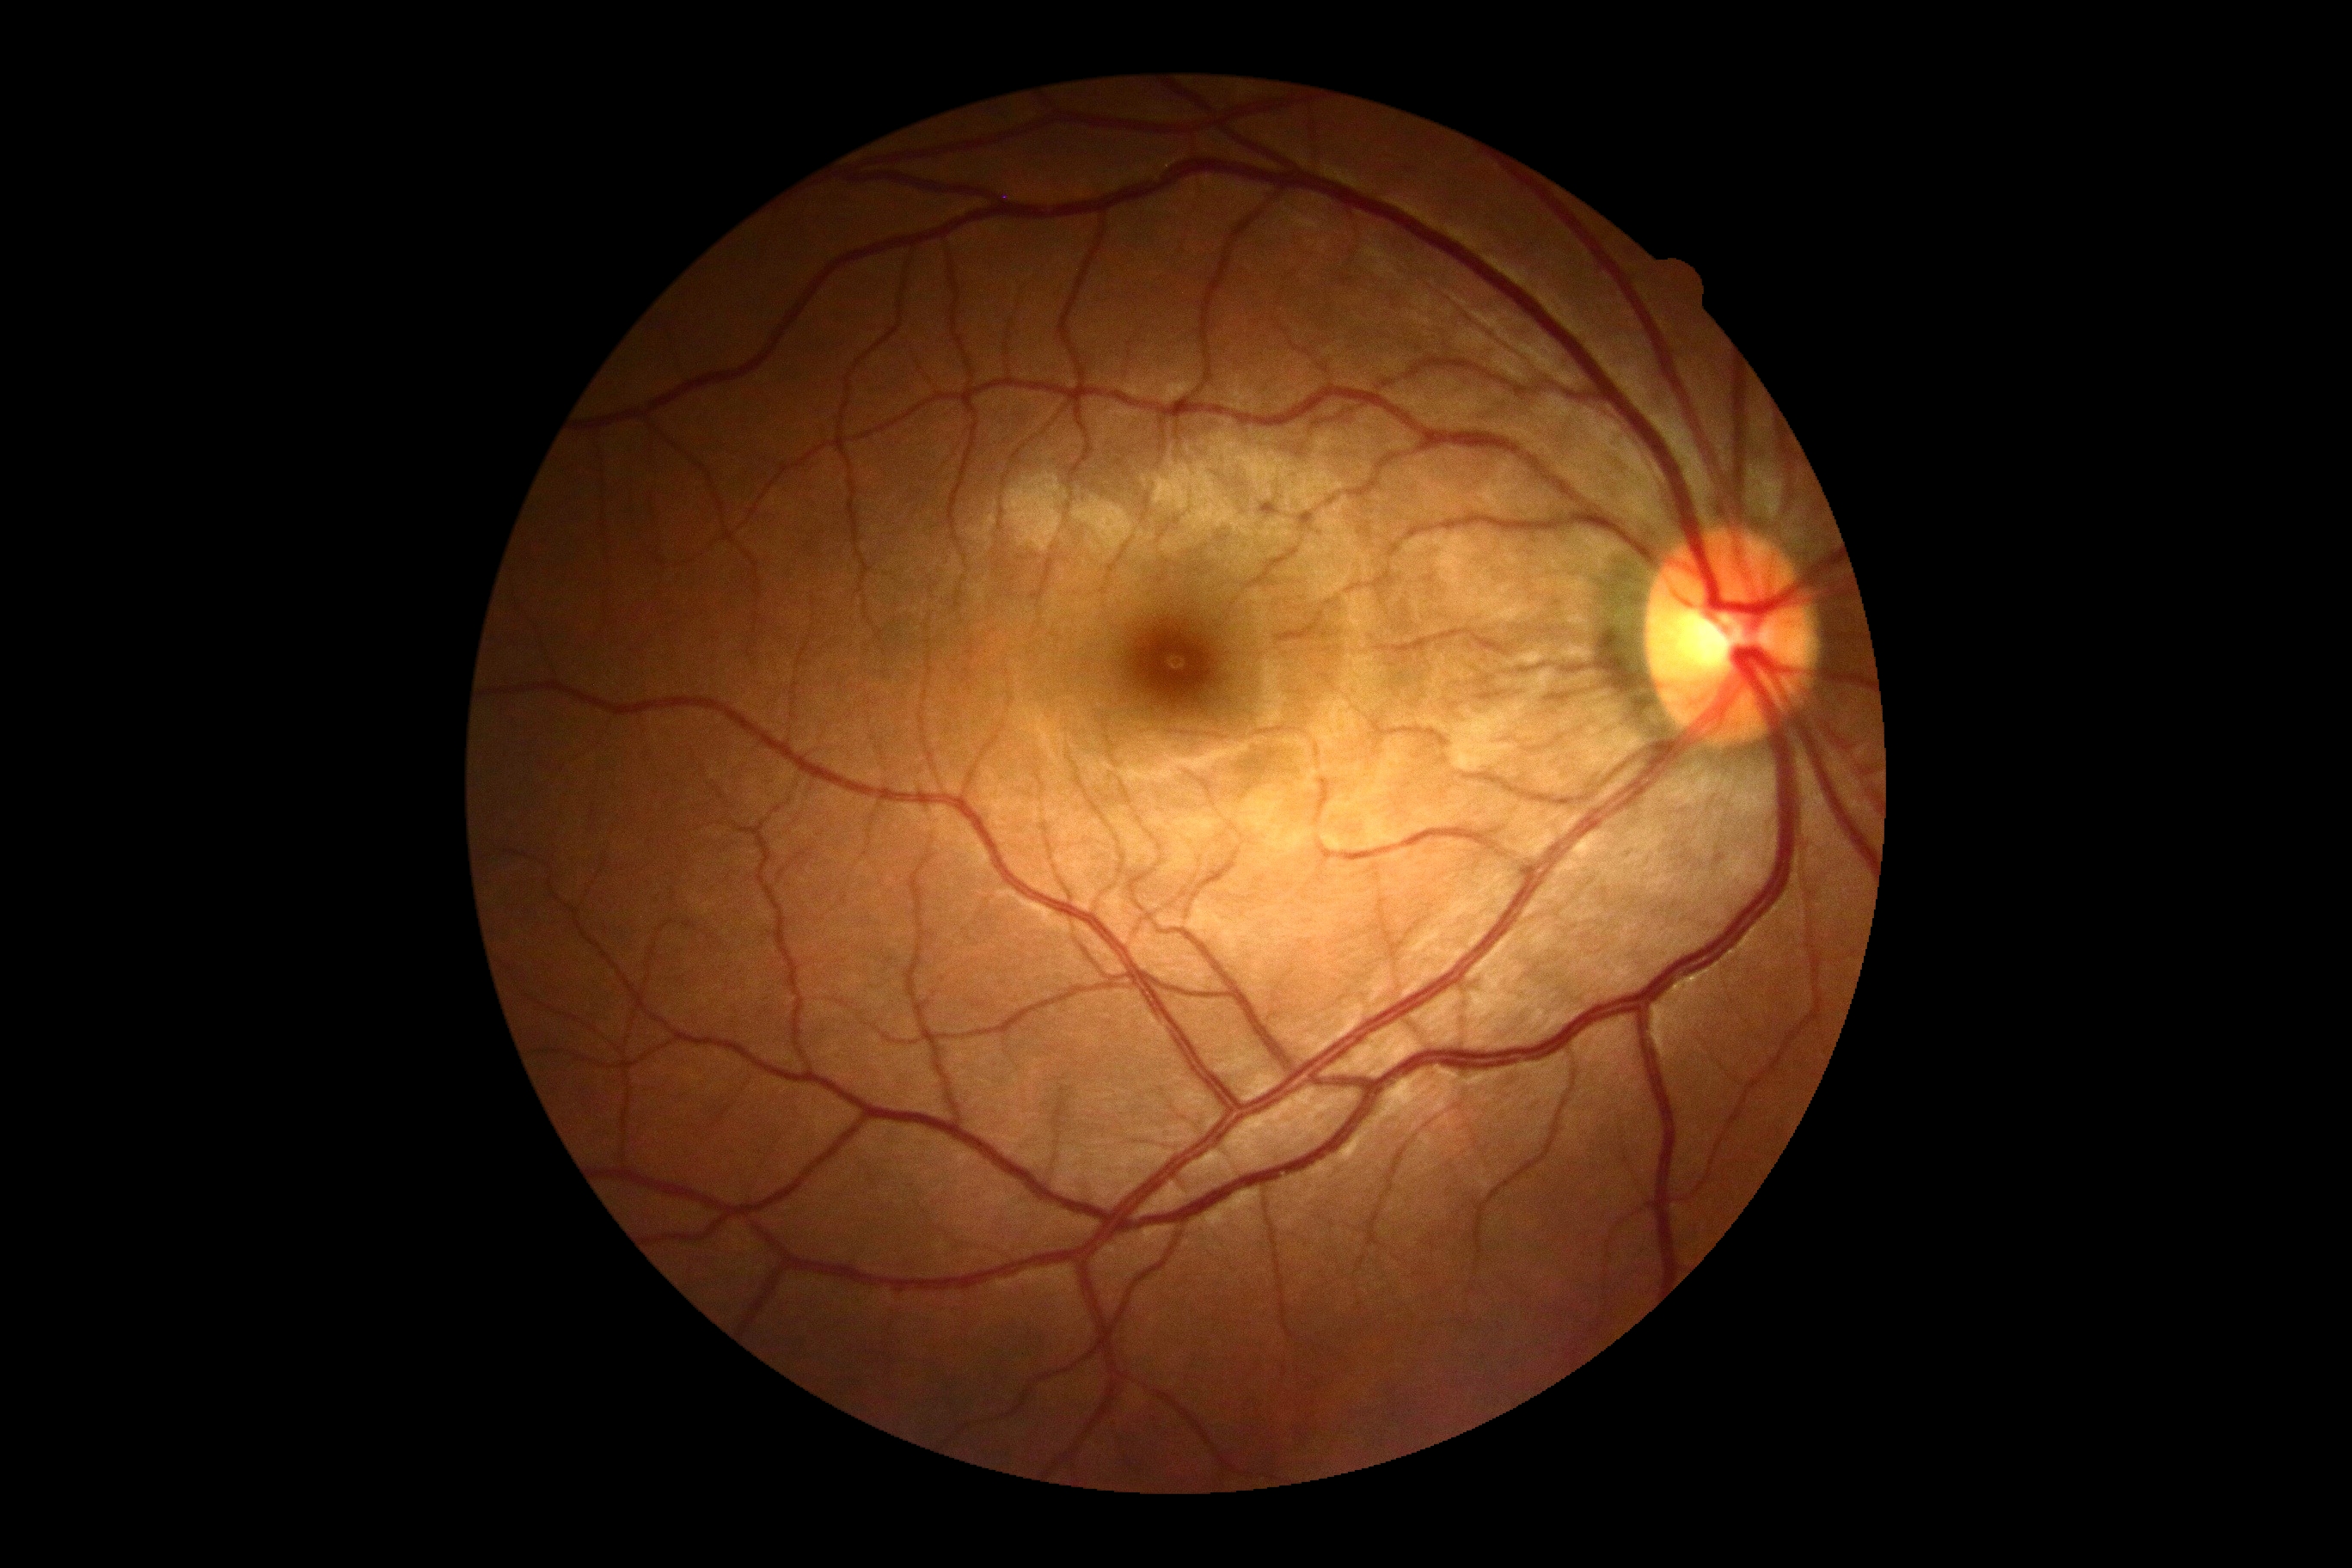 diabetic retinopathy = no apparent retinopathy (grade 0)